Image size 848x848:
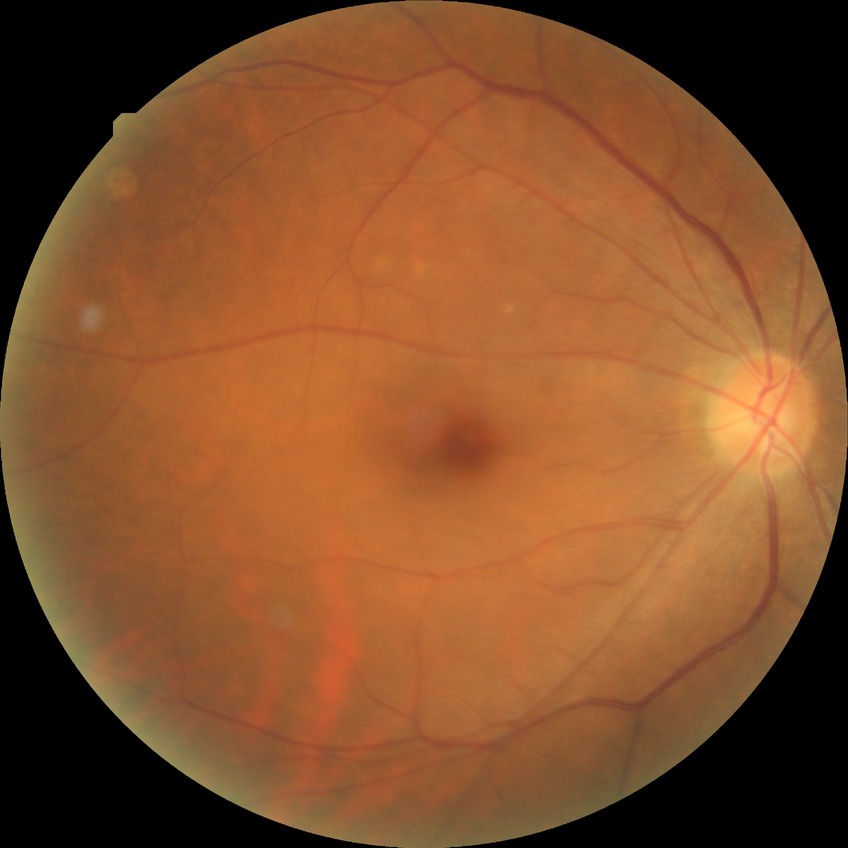
Diabetic retinopathy (DR): NDR (no diabetic retinopathy).